Color fundus image; 2102x1736px
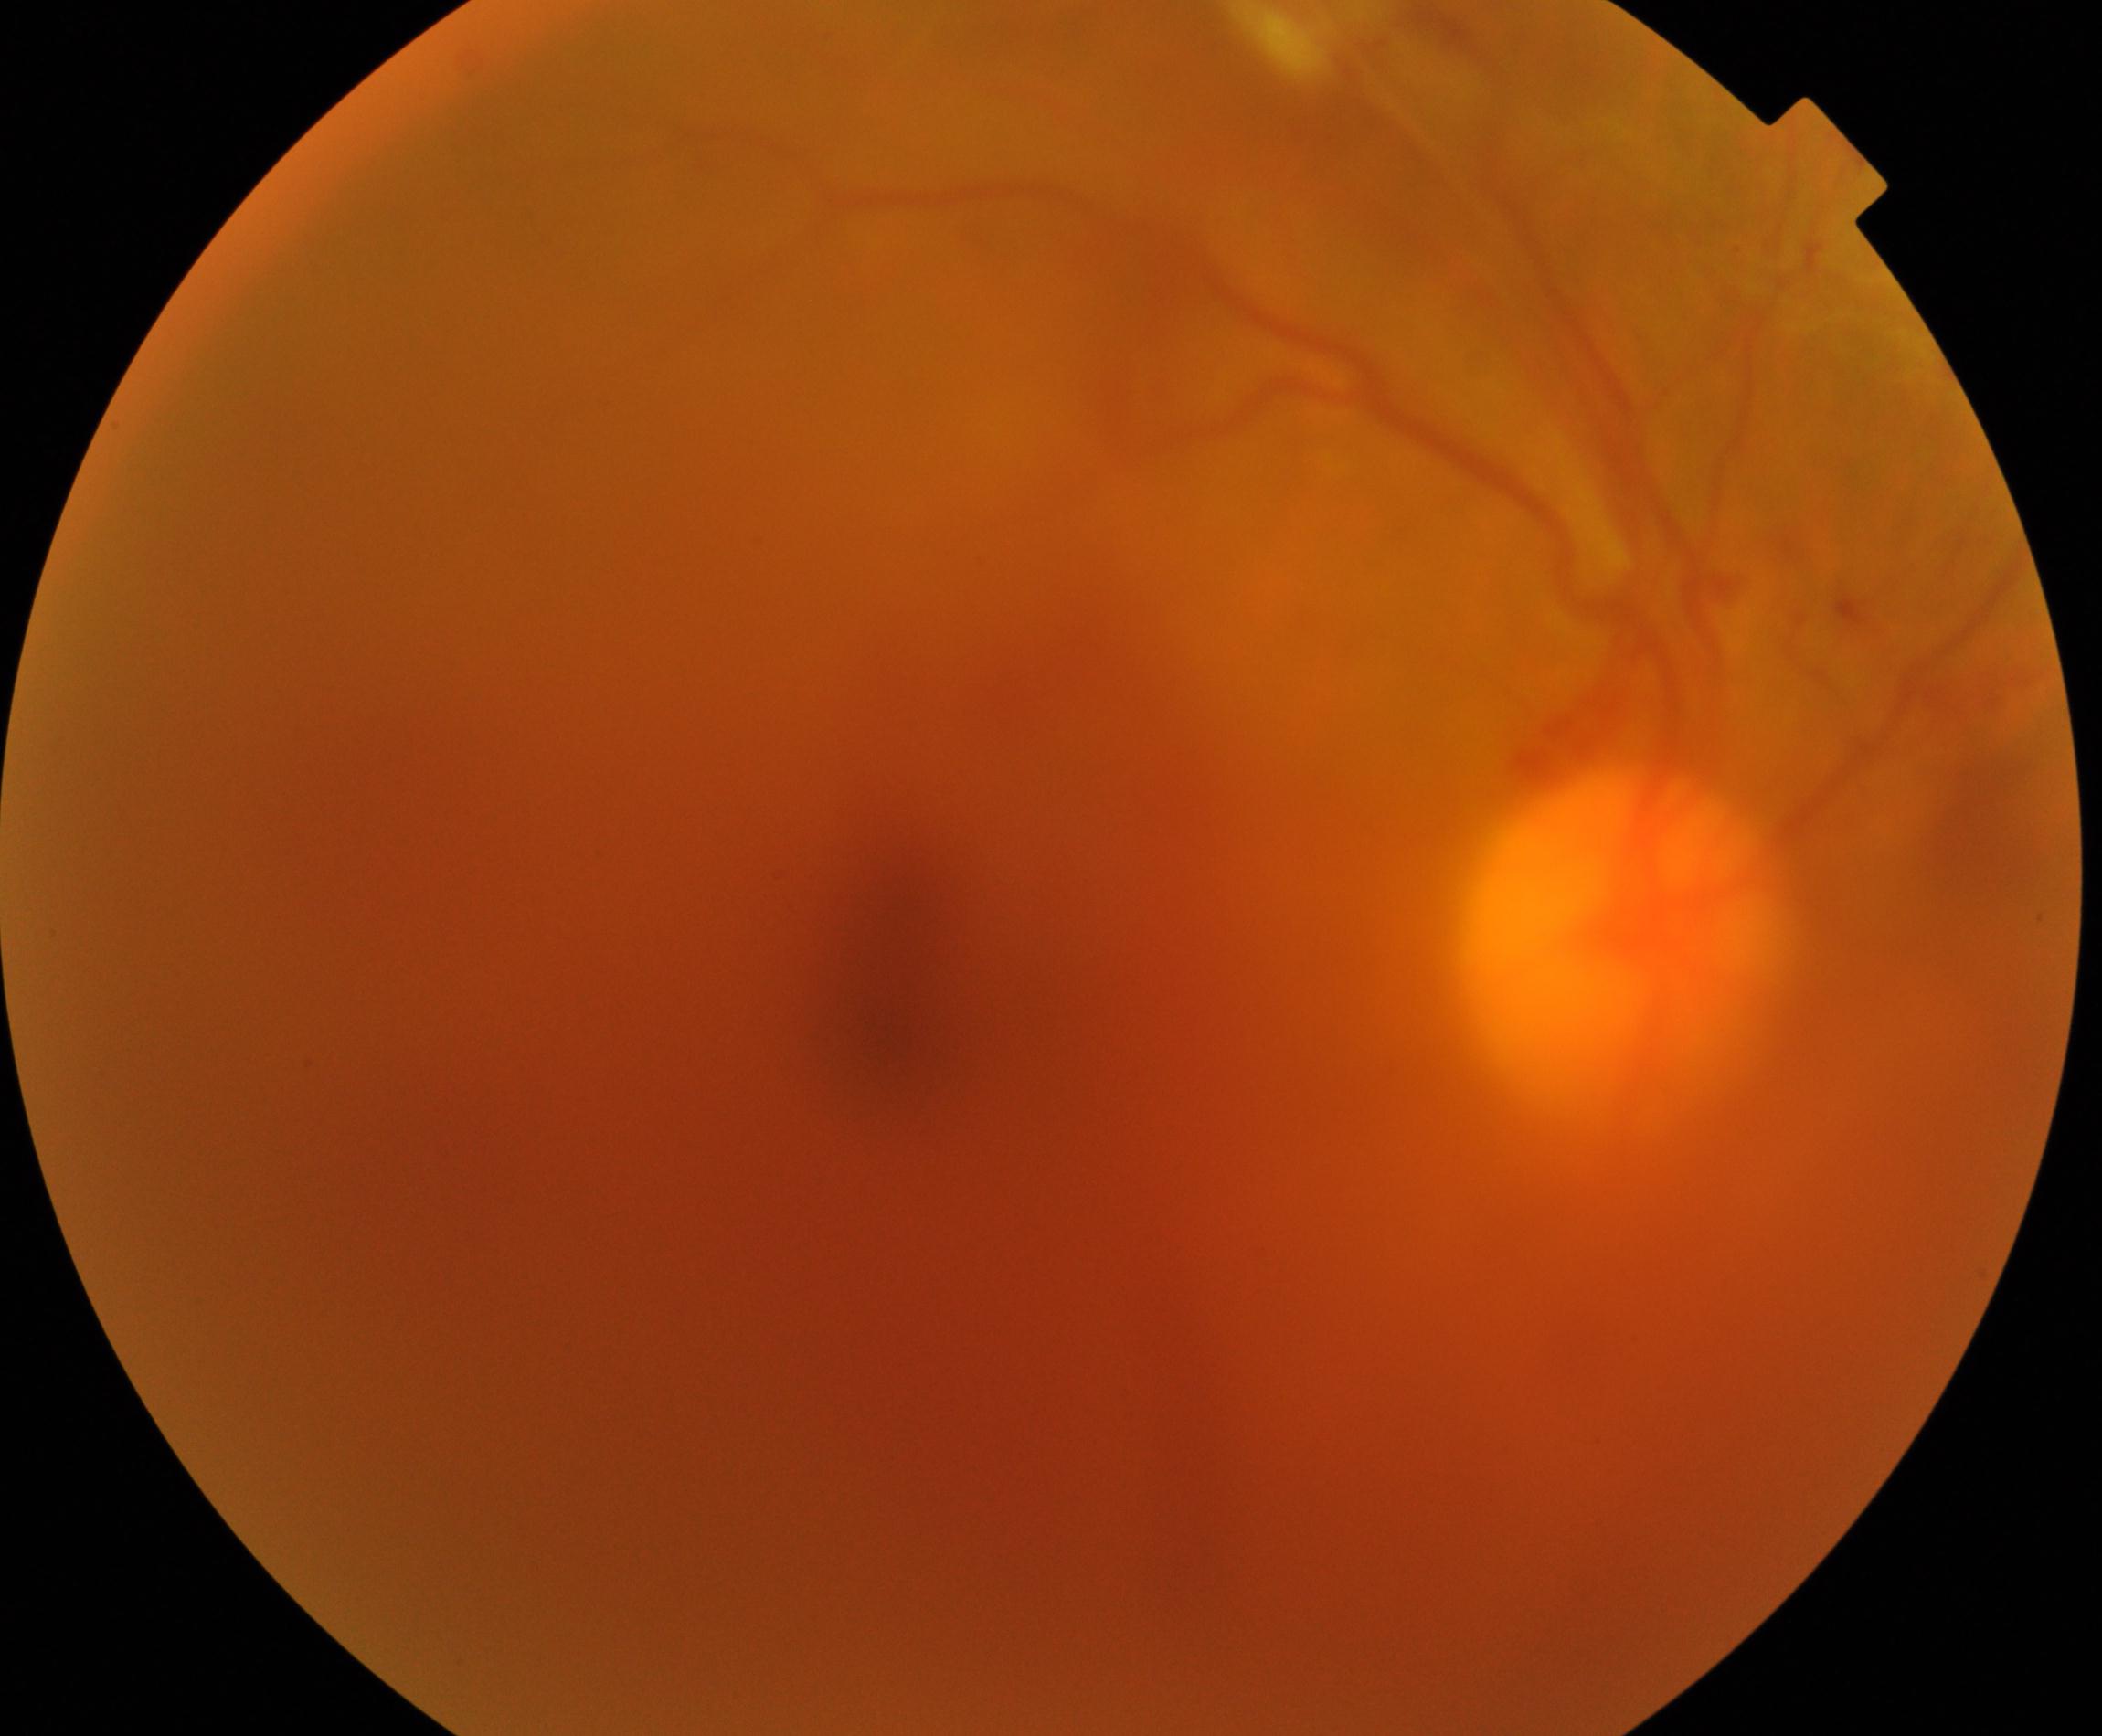

Image is blurred; retinal landmarks are largely obscured. Features suspicious for proliferative diabetic retinopathy.